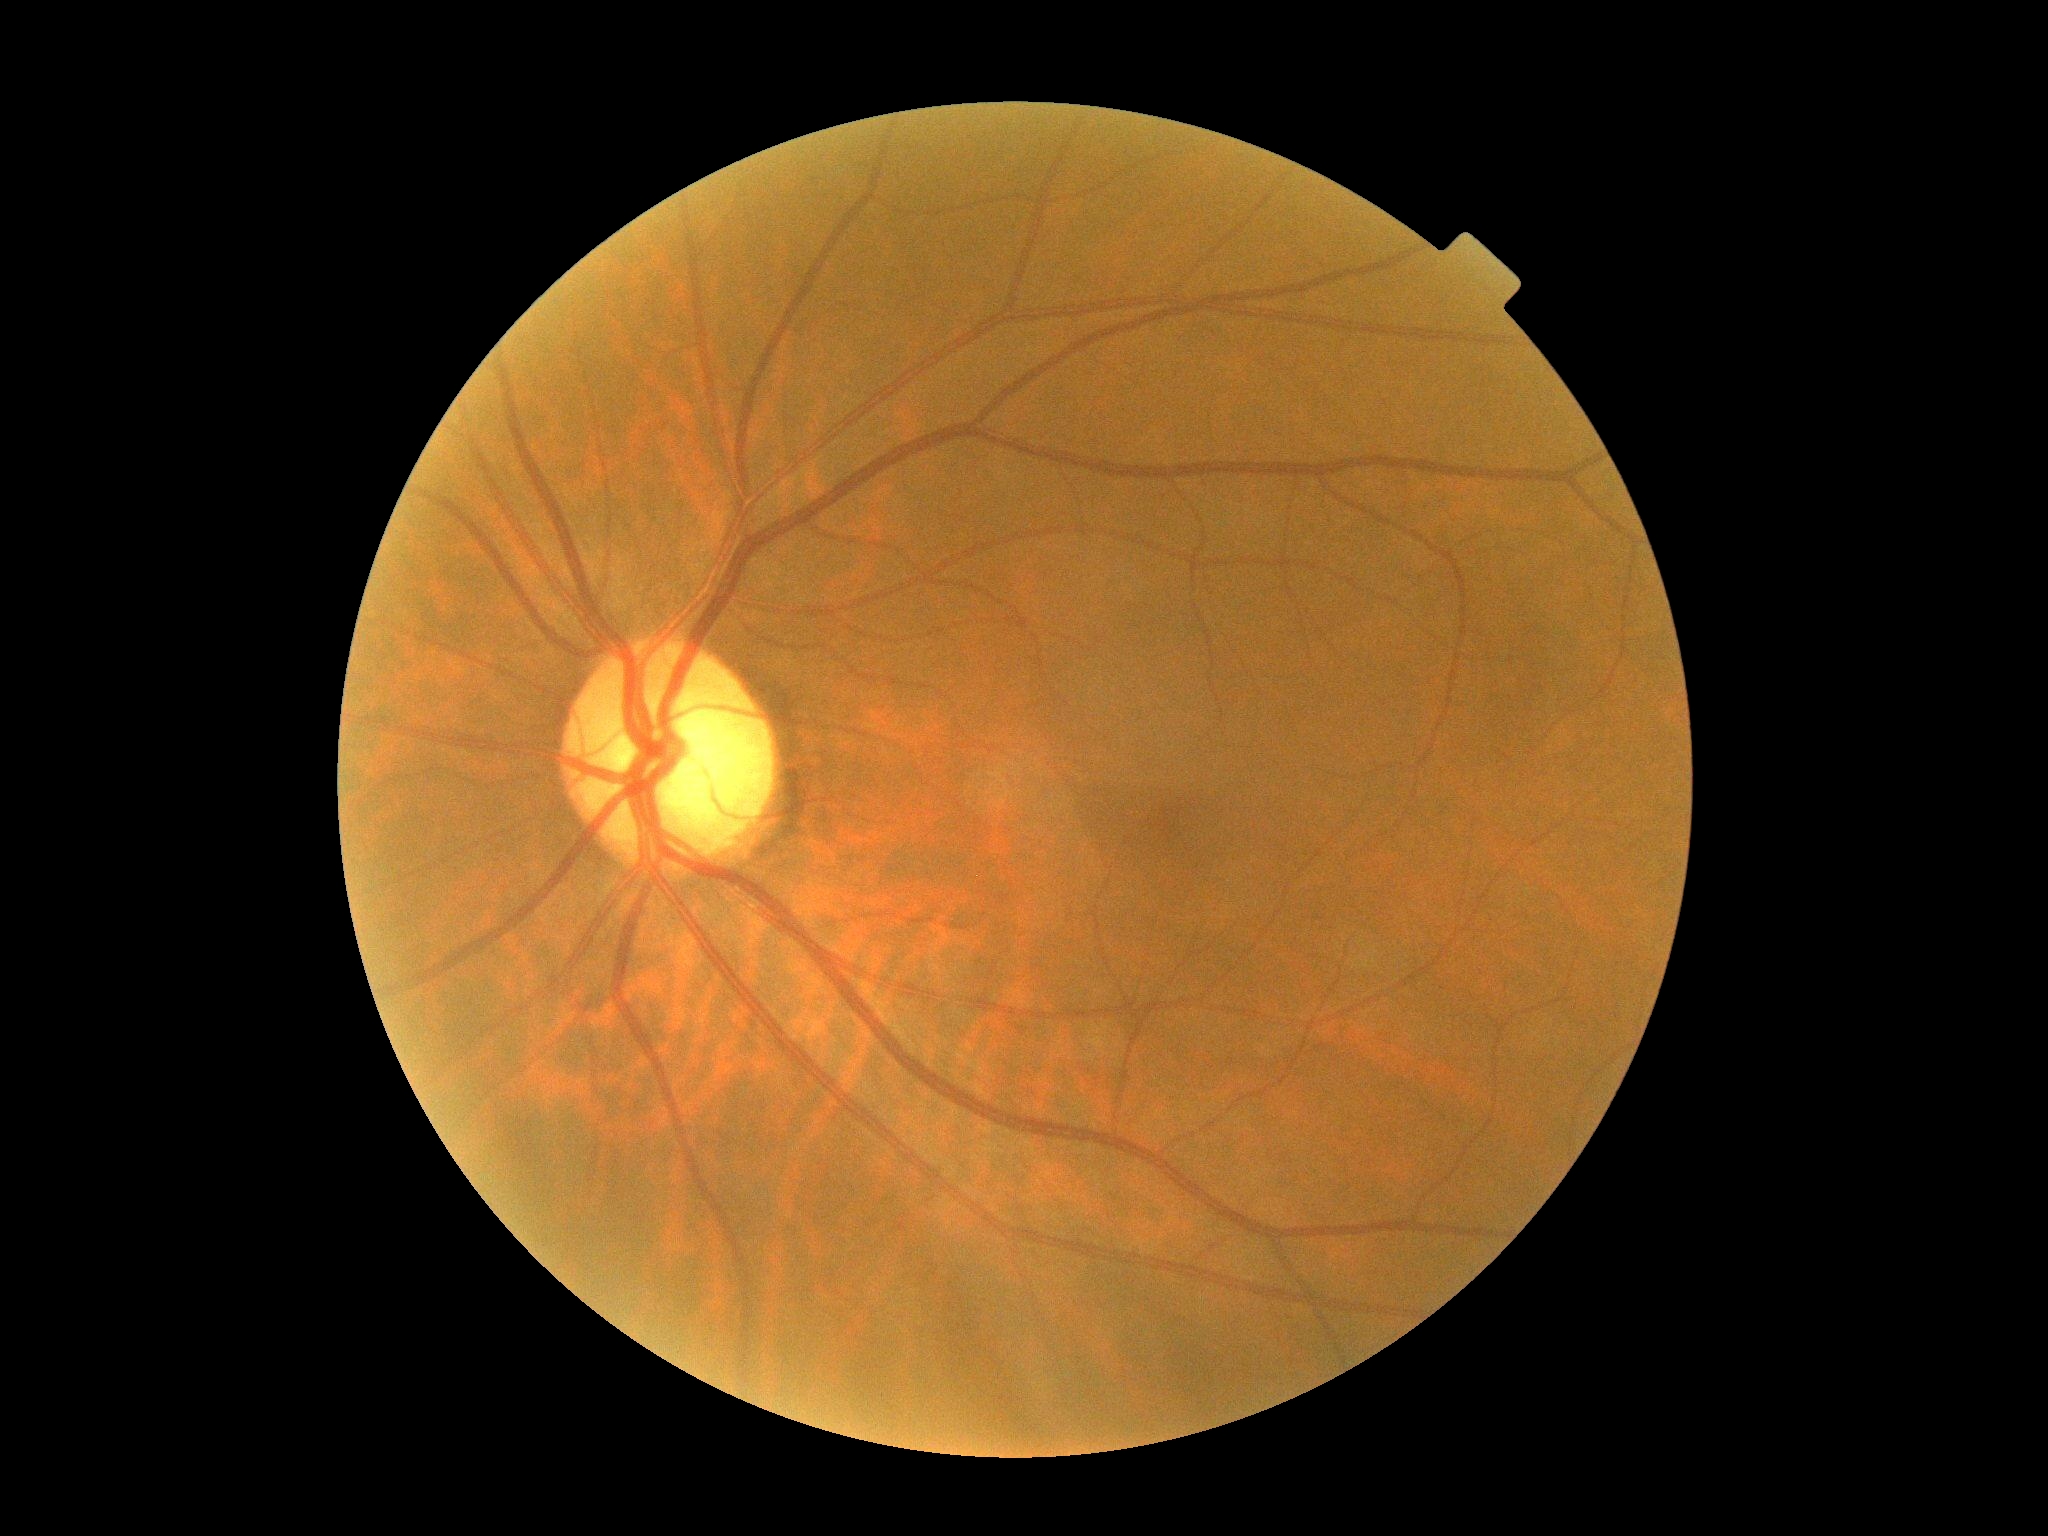
DR severity=0/4; DR impression=no signs of DR.